Image size 1470x1137.
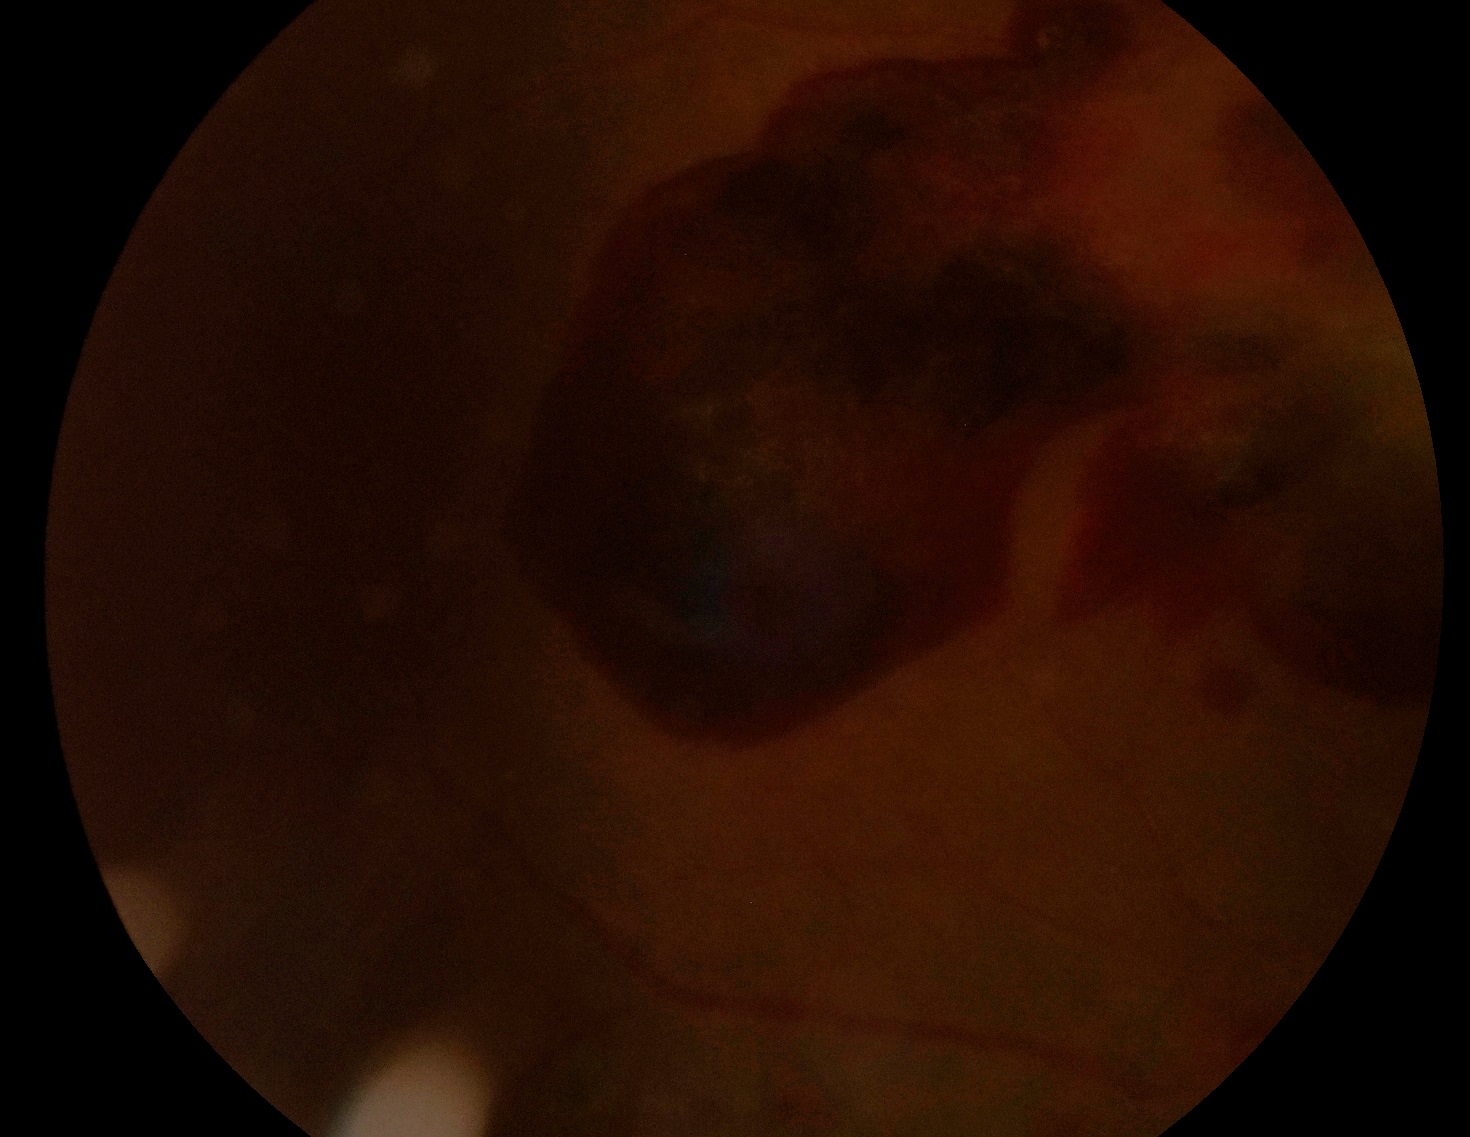 DR severity: grade 4 (PDR).